Nonmydriatic. Fundus photo. Modified Davis classification.
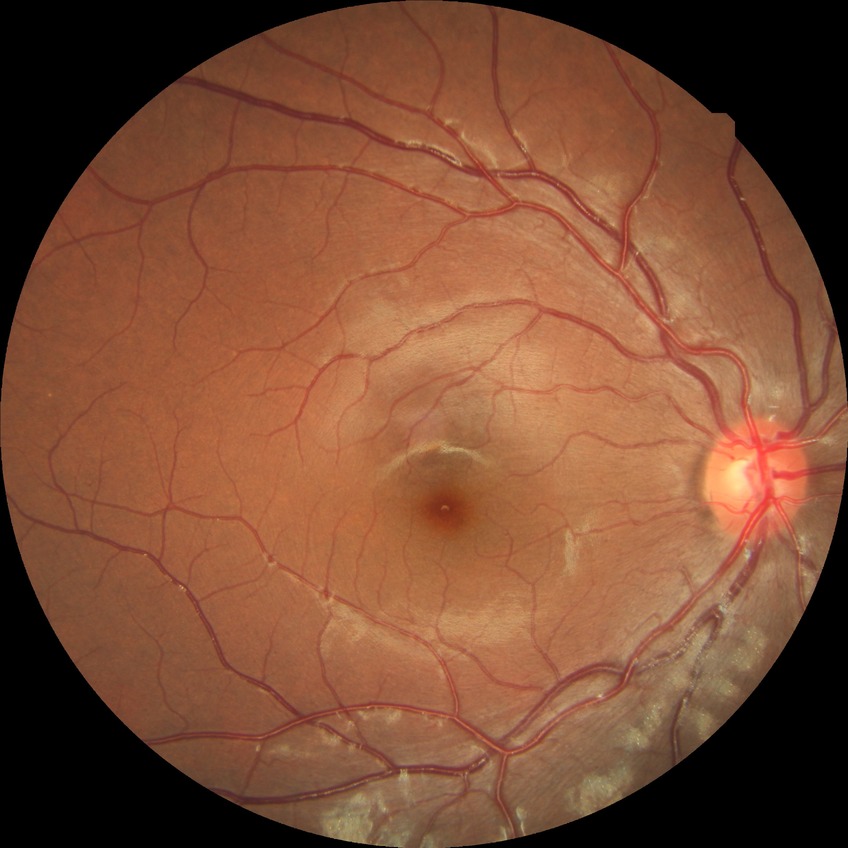

  davis_grade: simple diabetic retinopathy